Infant wide-field fundus photograph. Image size 1240x1240: 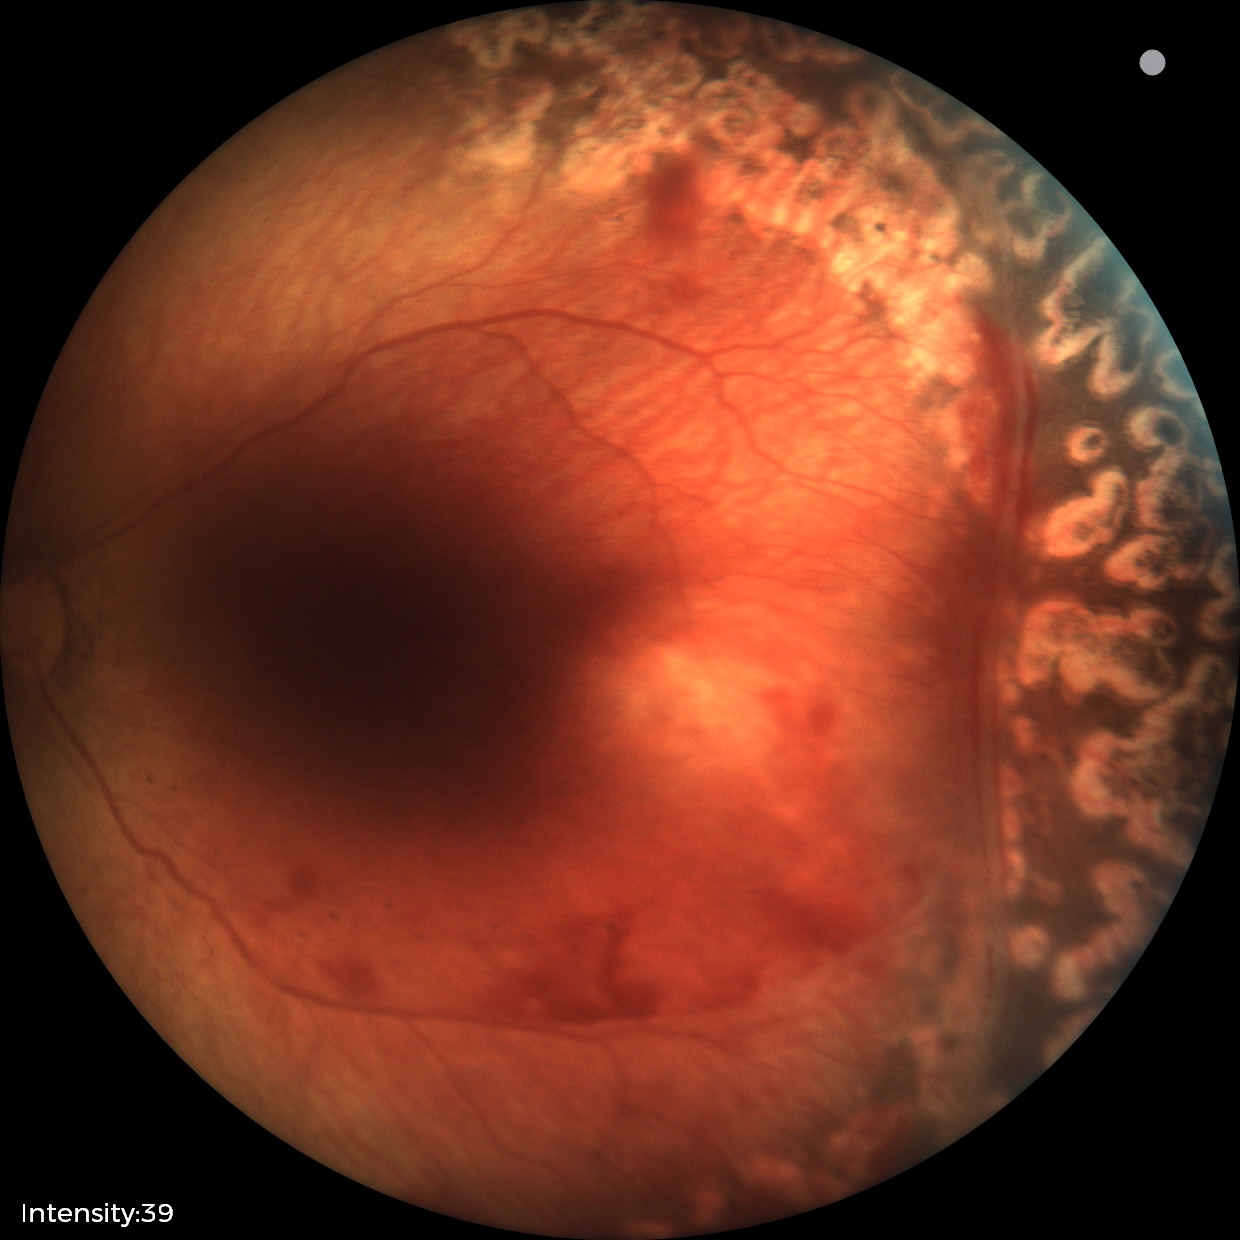
From an examination with diagnosis of status post retinopathy of prematurity — retinal appearance after treated retinopathy of prematurity.